Retinal fundus photograph · acquired with a Topcon TRC-NW8.
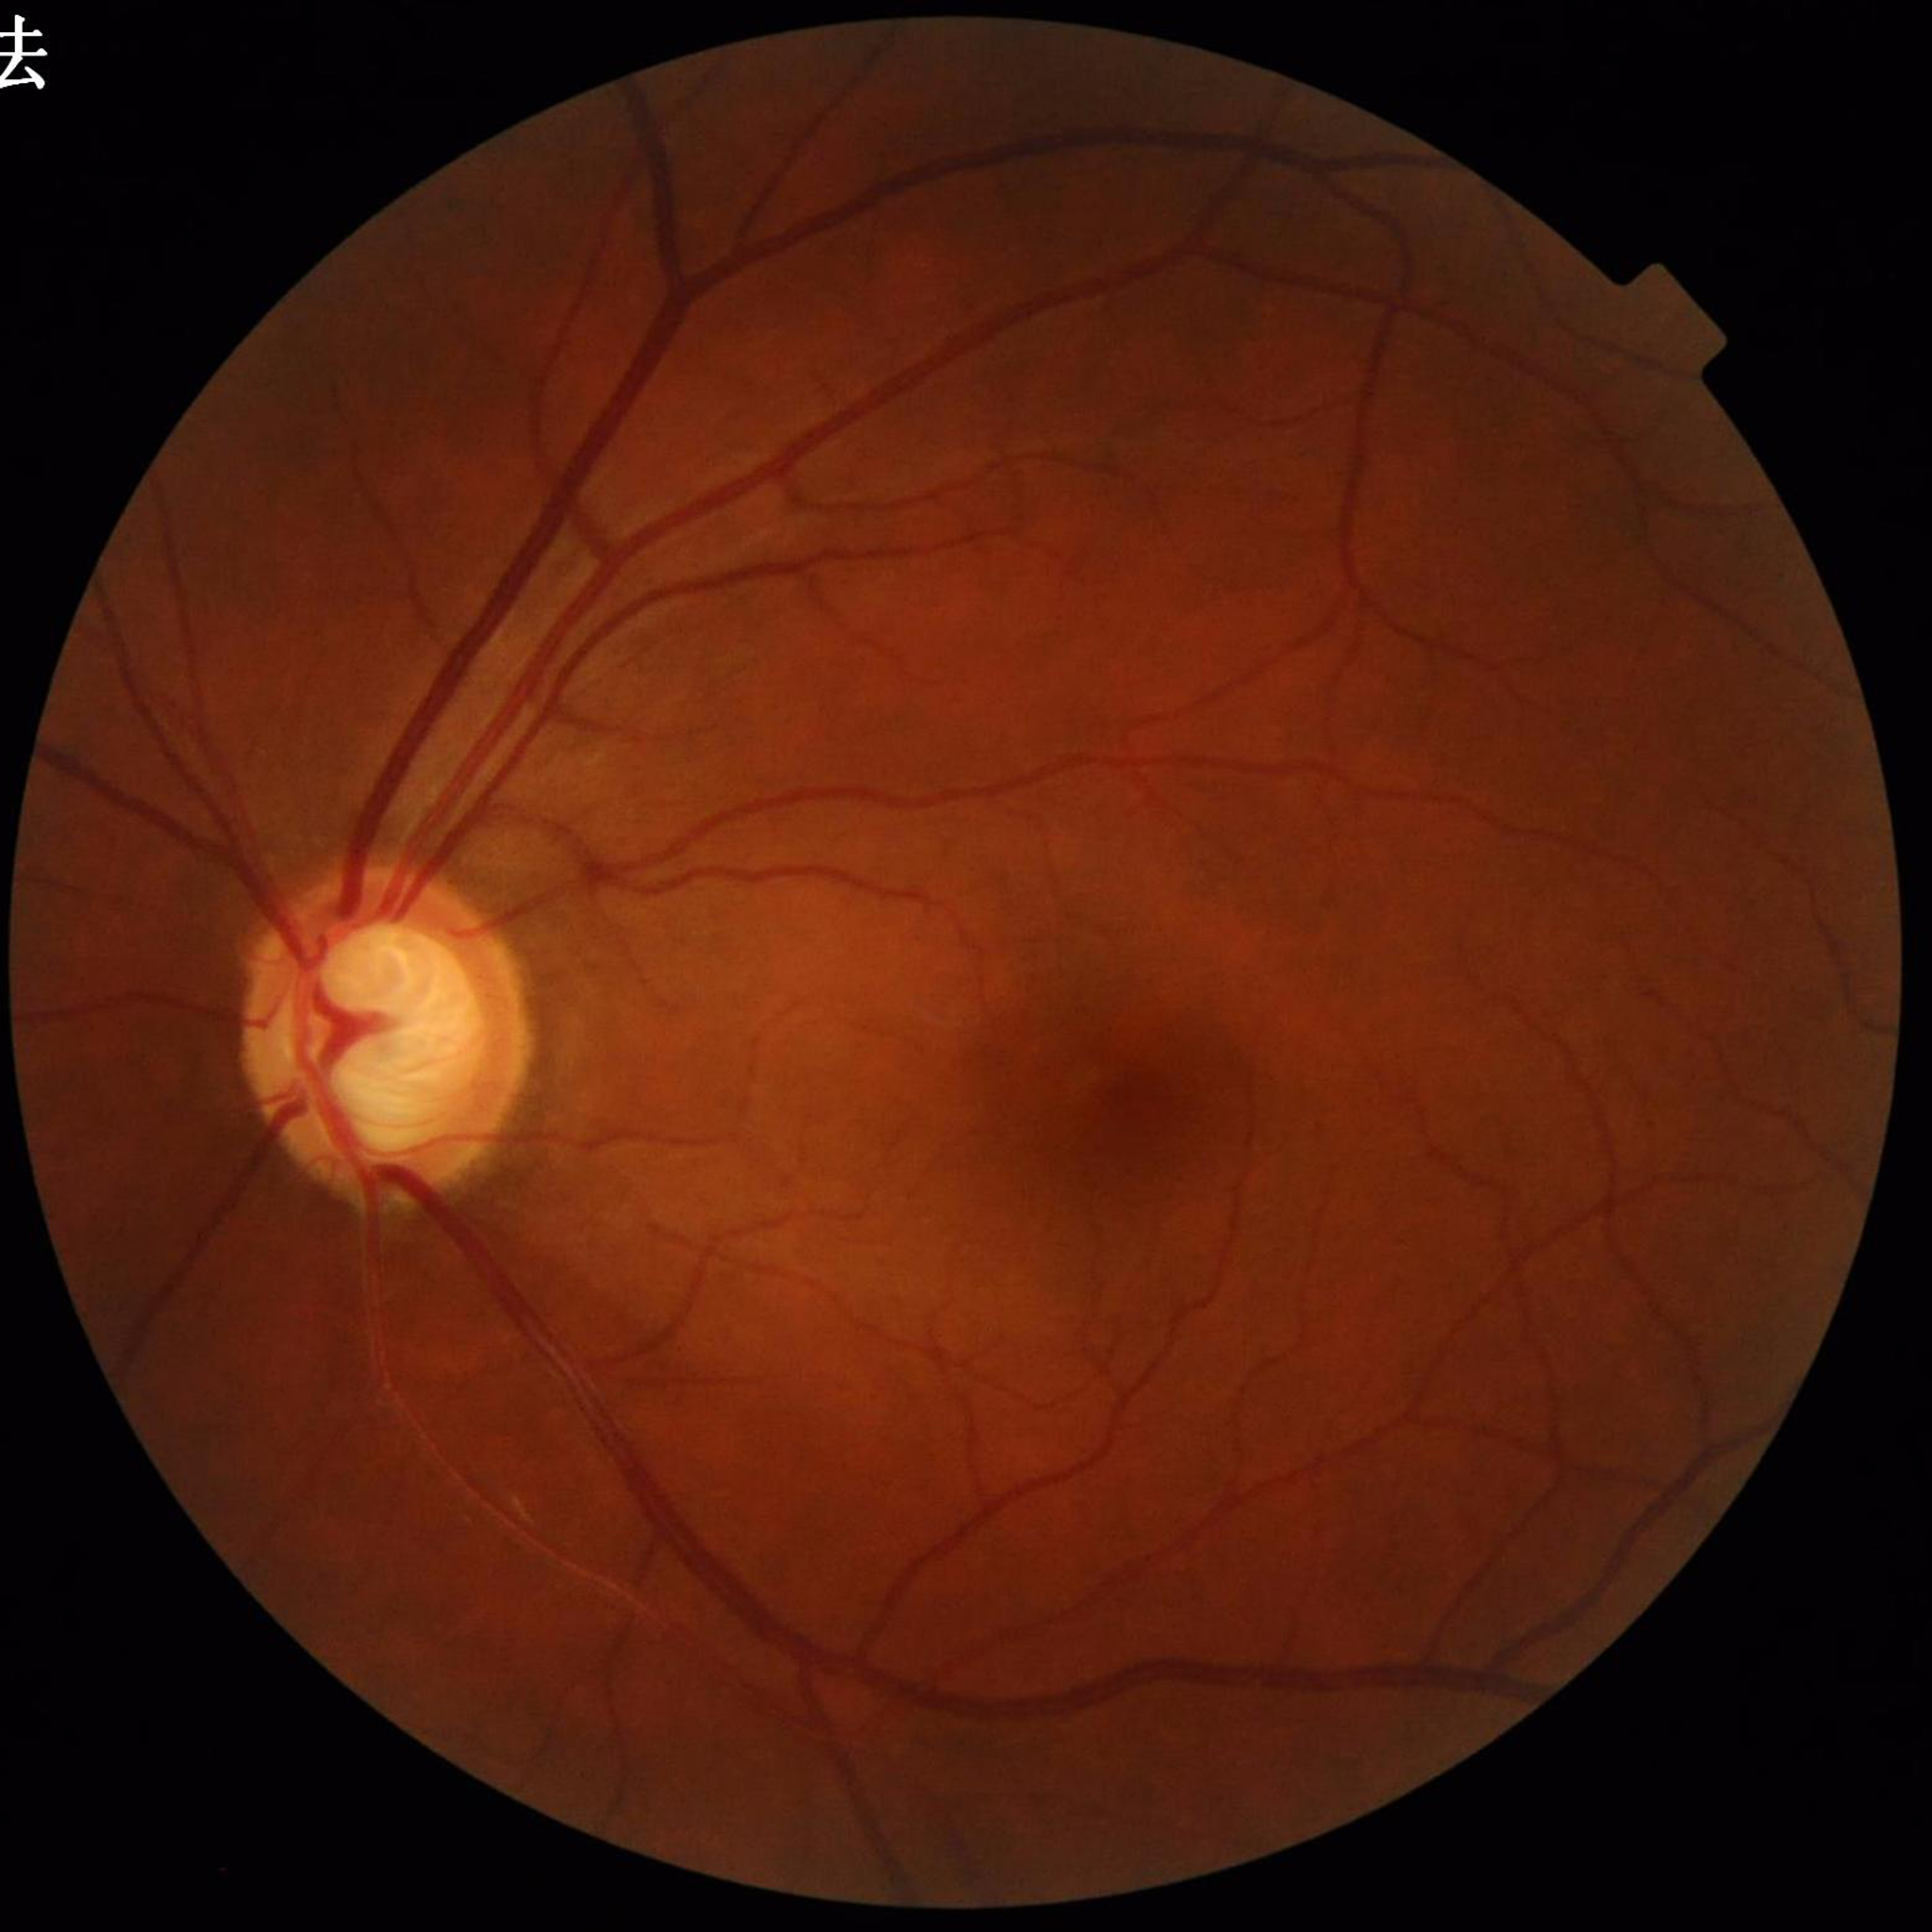

diagnosis: glaucoma